FOV: 45 degrees: 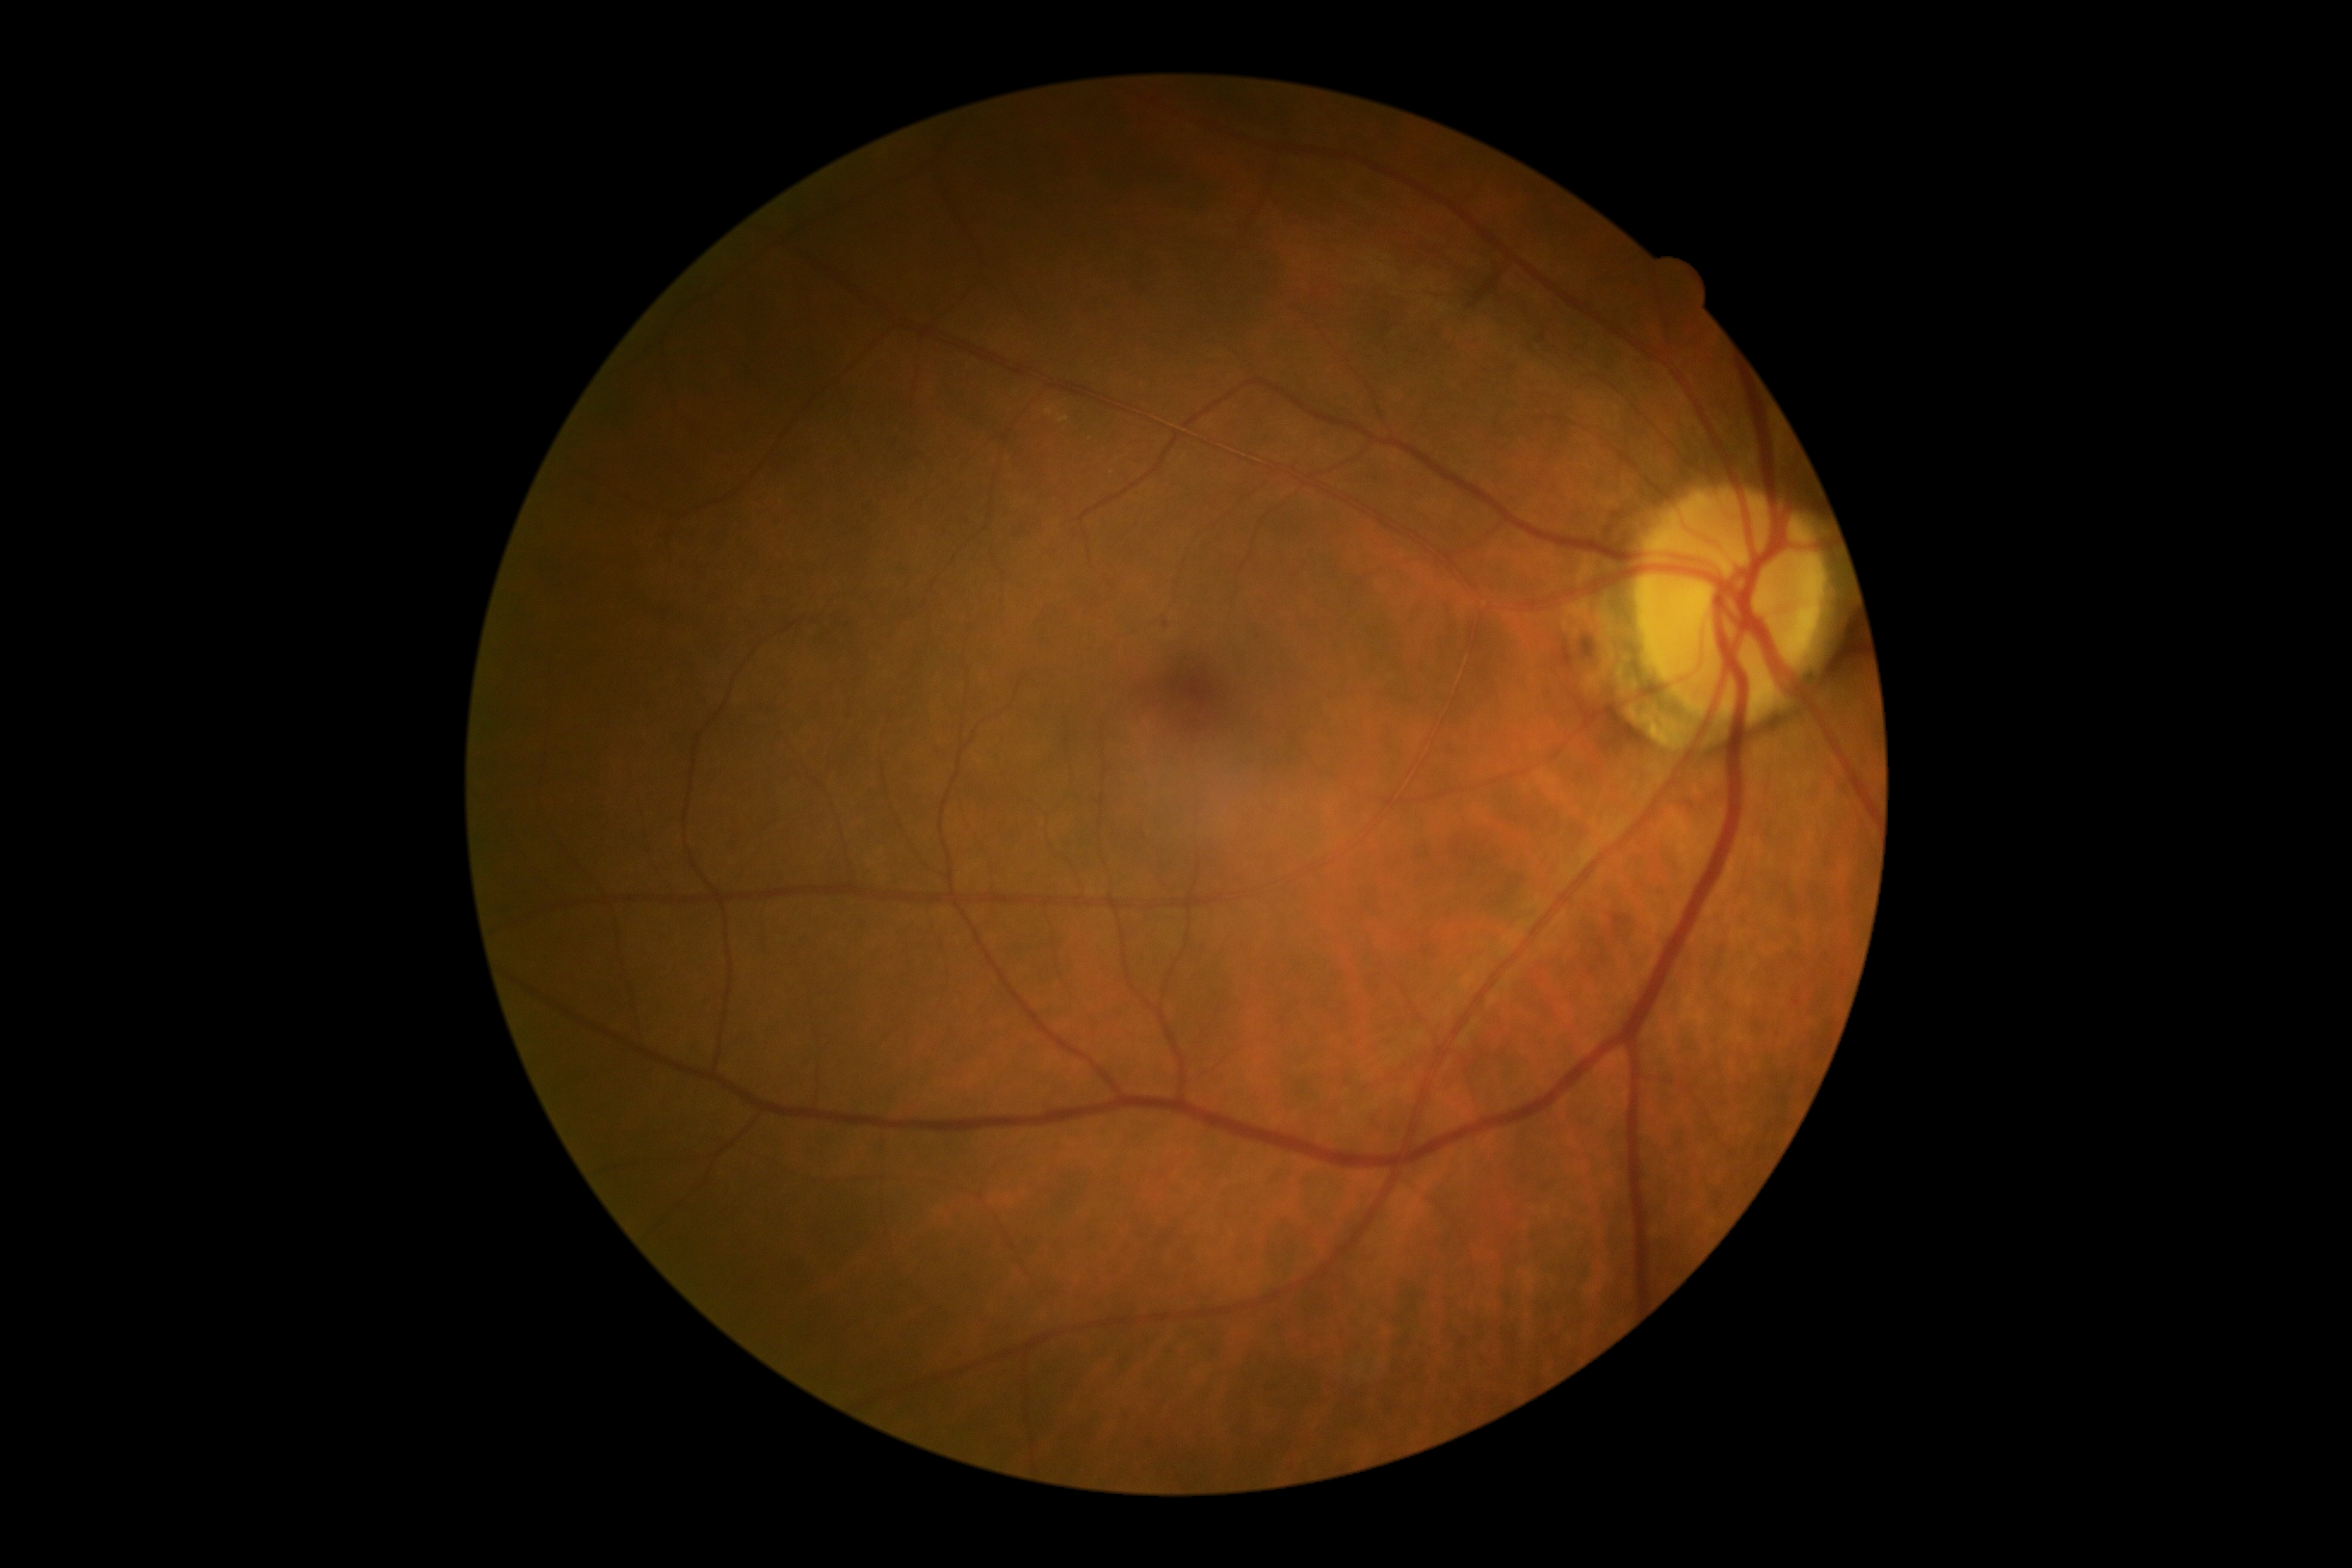 Diabetic retinopathy is grade 1 (mild NPDR).